FOV: 60 degrees. Portable fundus camera image: 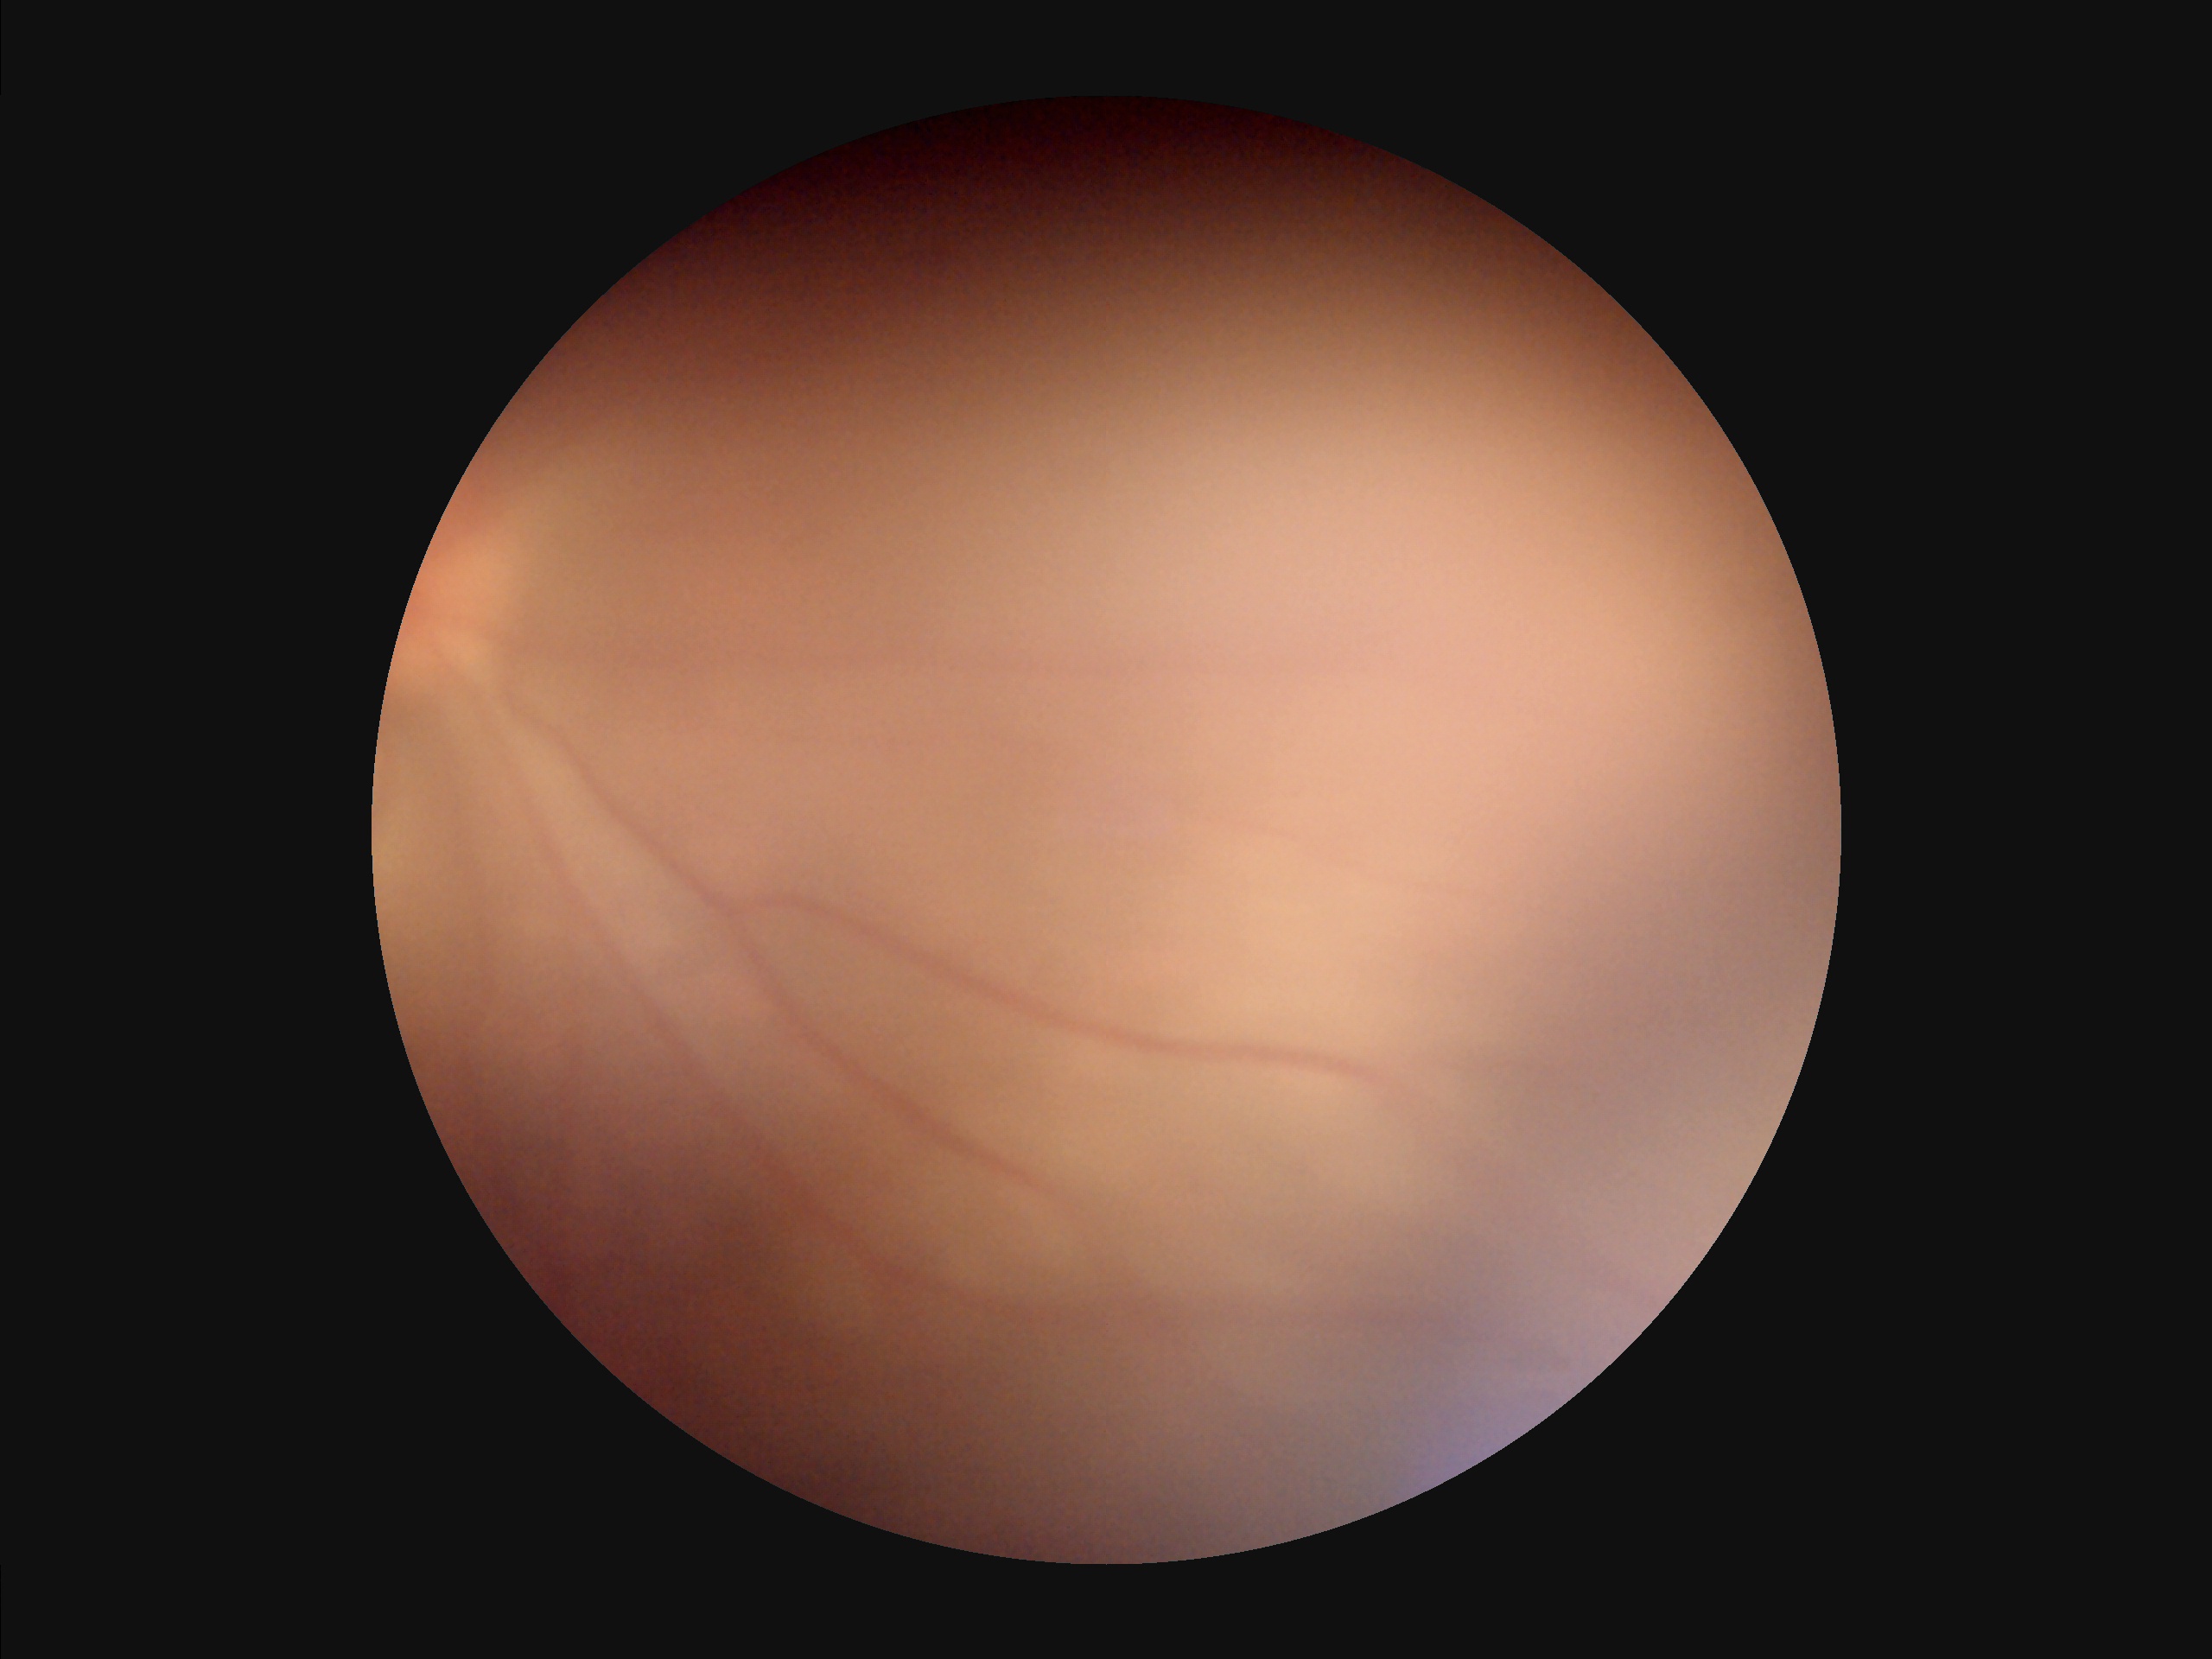 Noticeable blur in the optic disc, vessels, or background. Image quality is suboptimal. Vessels and details are hard to distinguish. There is over- or under-exposure or a color cast.